Wide-field fundus photograph from neonatal ROP screening:
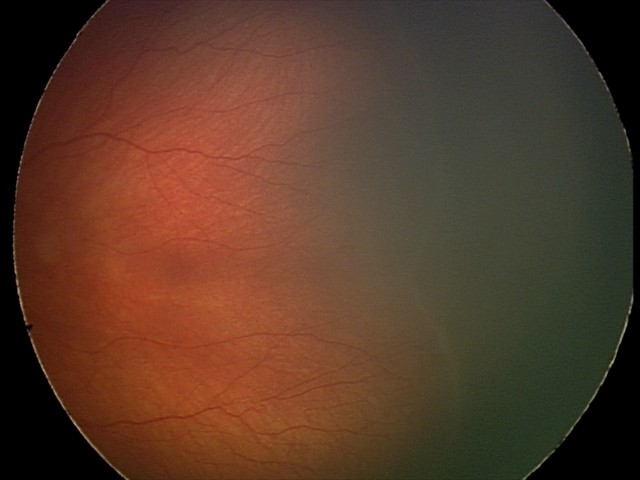
Retinopathy of prematurity: stage 2.